Image size 2352x1568:
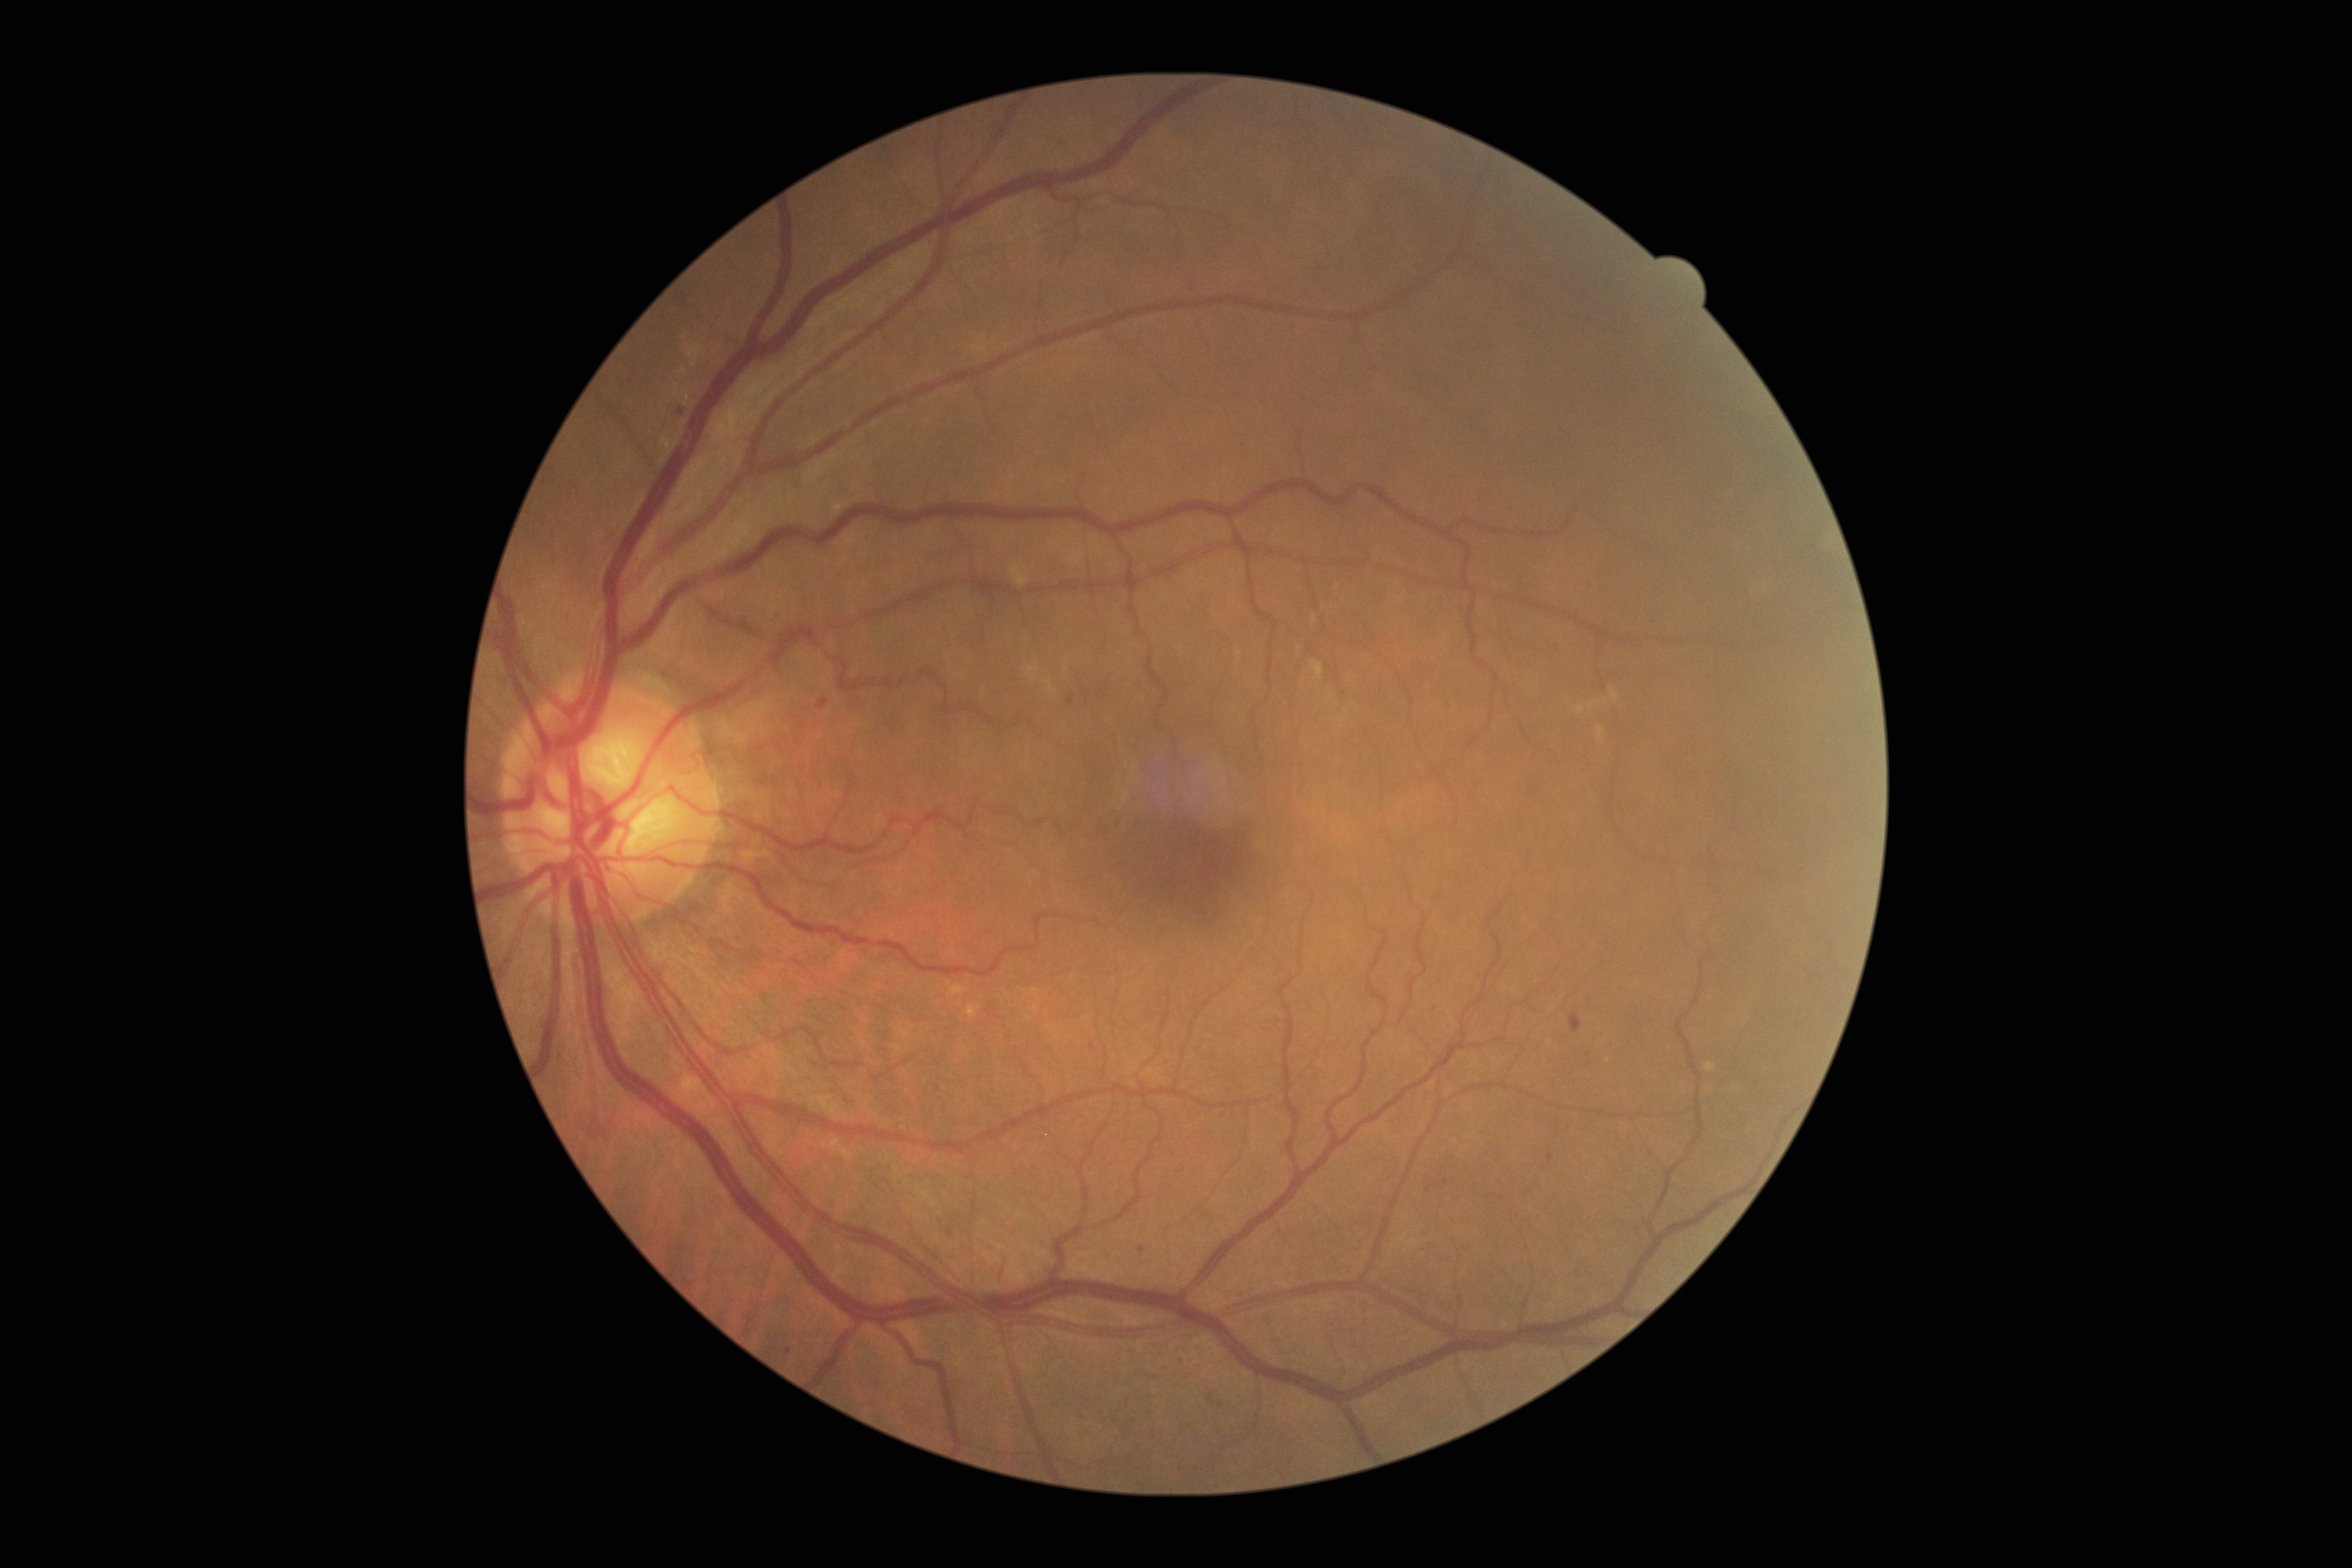
<lesions partial="true">
  <dr_grade>1</dr_grade>
  <ex />
  <ma partial="true">box(1152, 1375, 1160, 1380) | box(817, 697, 828, 710) | box(1069, 694, 1074, 706) | box(1570, 1014, 1581, 1033) | box(1173, 1357, 1184, 1363) | box(1547, 1152, 1553, 1163) | box(678, 408, 684, 416)</ma>
  <ma_small_approx>[1429, 1188] | [789, 1350] | [1141, 1249] | [1163, 1367] | [1445, 1181]</ma_small_approx>
  <se />
  <he>box(832, 1060, 866, 1069) | box(591, 1119, 608, 1137)</he>
  <he_small_approx>[815, 1065]</he_small_approx>
</lesions>